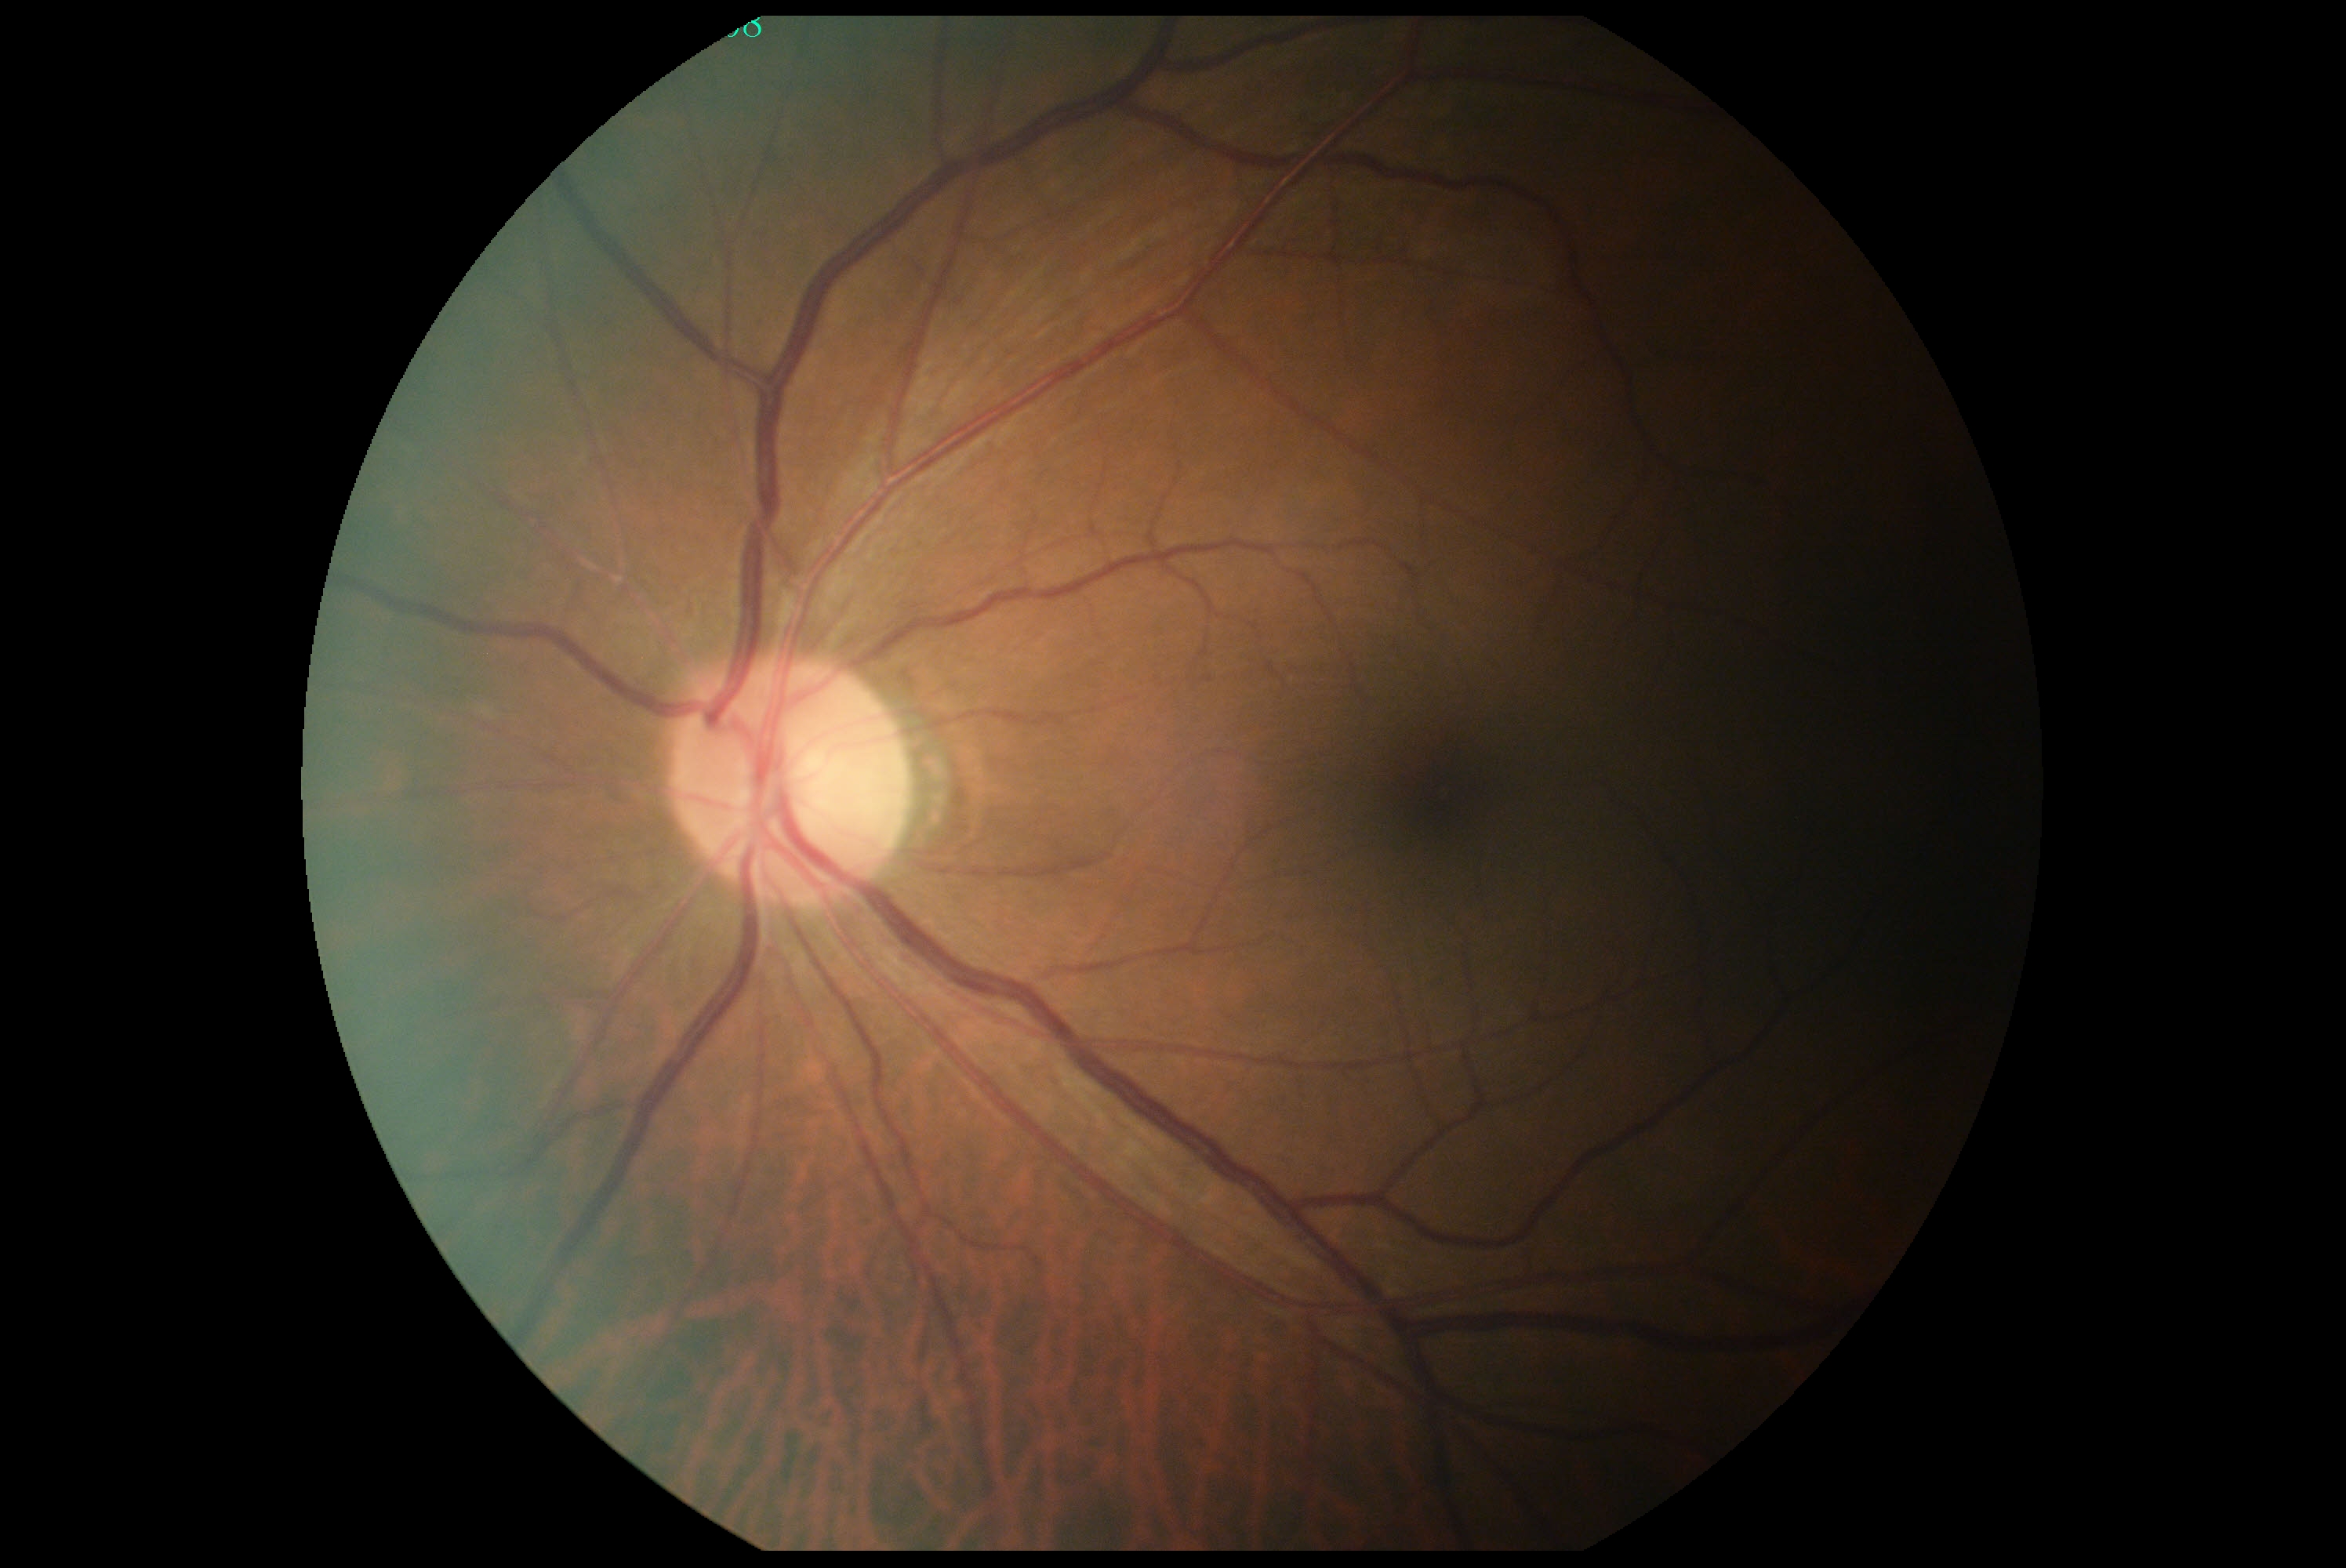

No diabetic retinal disease findings.
Retinopathy is grade 0.